Wide-field contact fundus photograph of an infant. 1240x1240 — 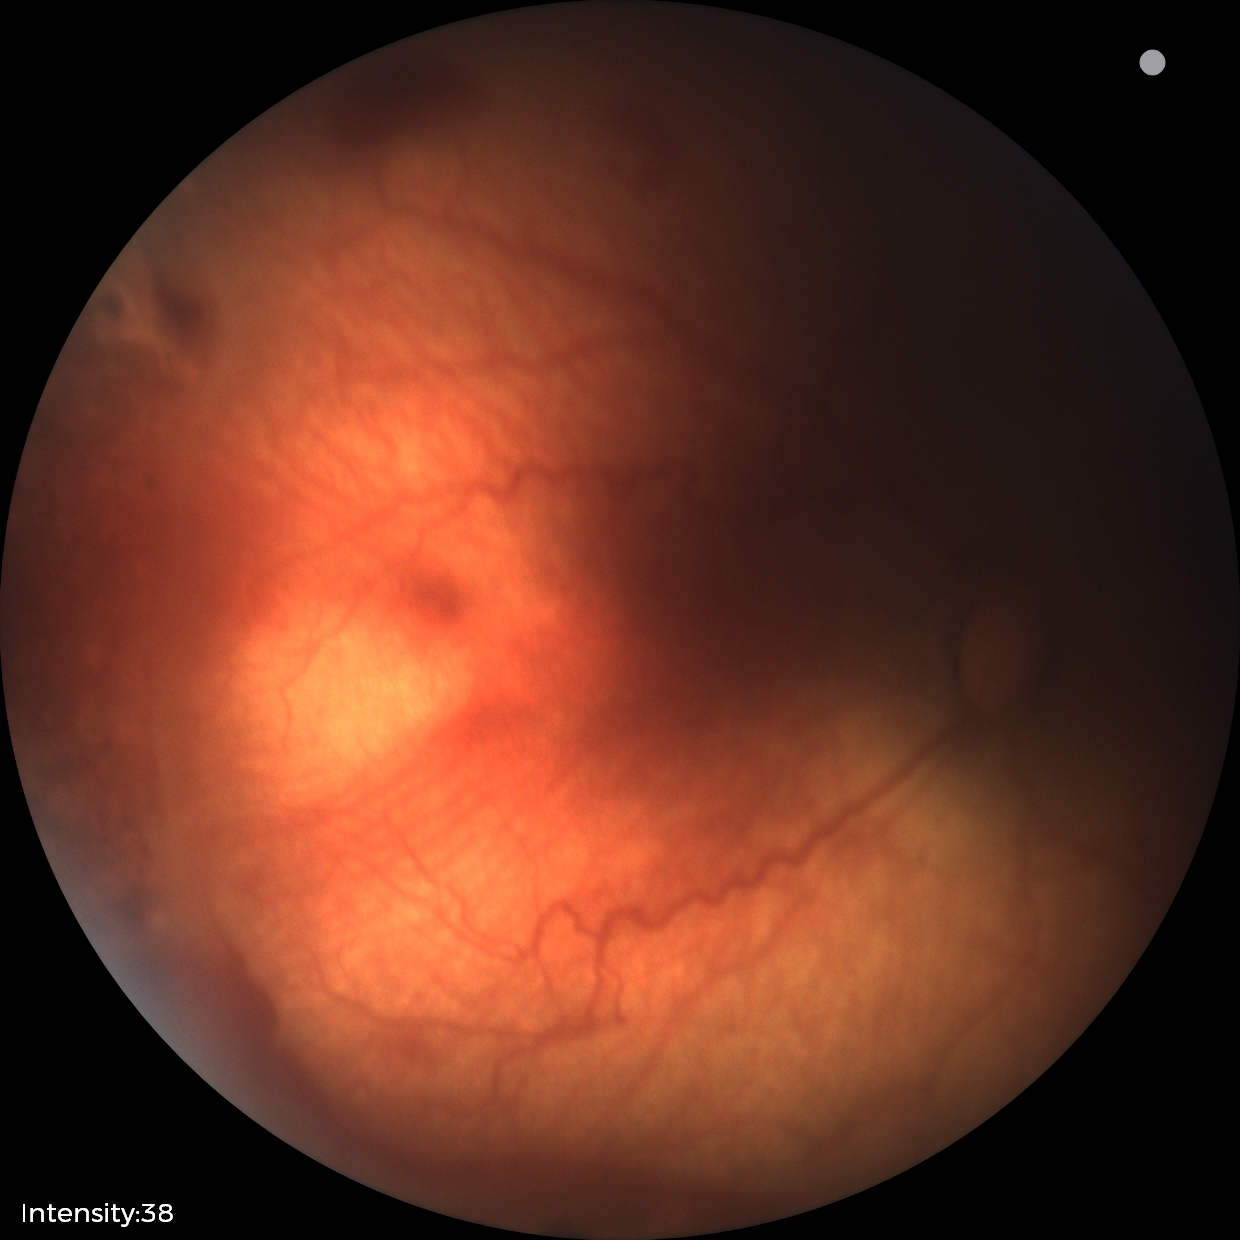
Plus disease absent. Screening series with status post ROP.